Camera: NIDEK AFC-230. 45 degree fundus photograph
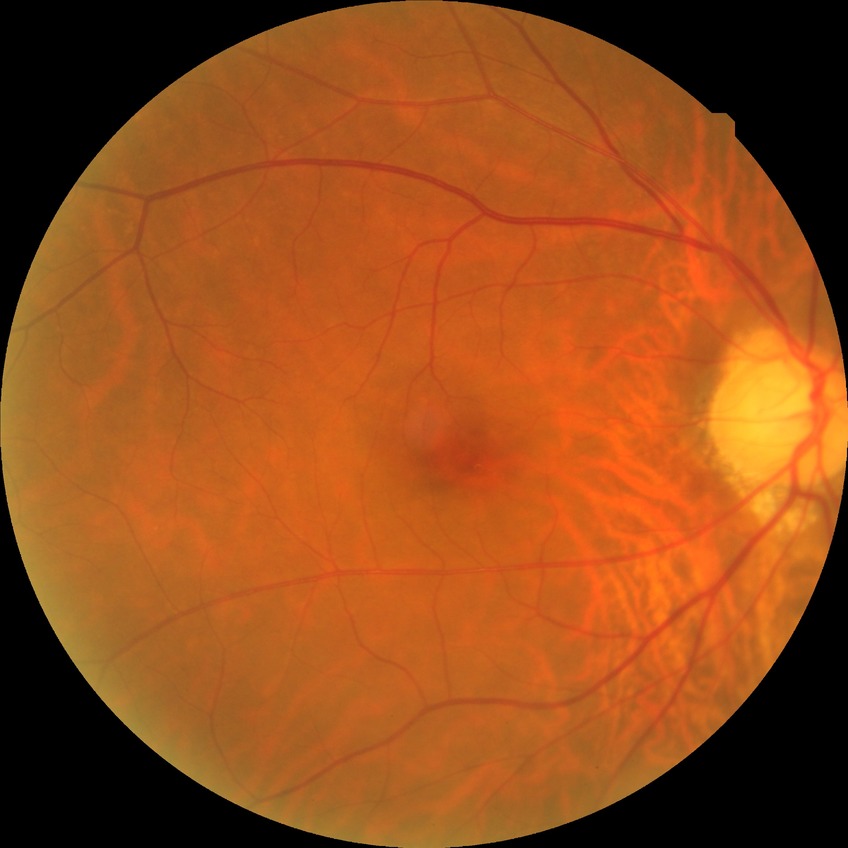
diabetic retinopathy (DR) = no diabetic retinopathy (NDR).